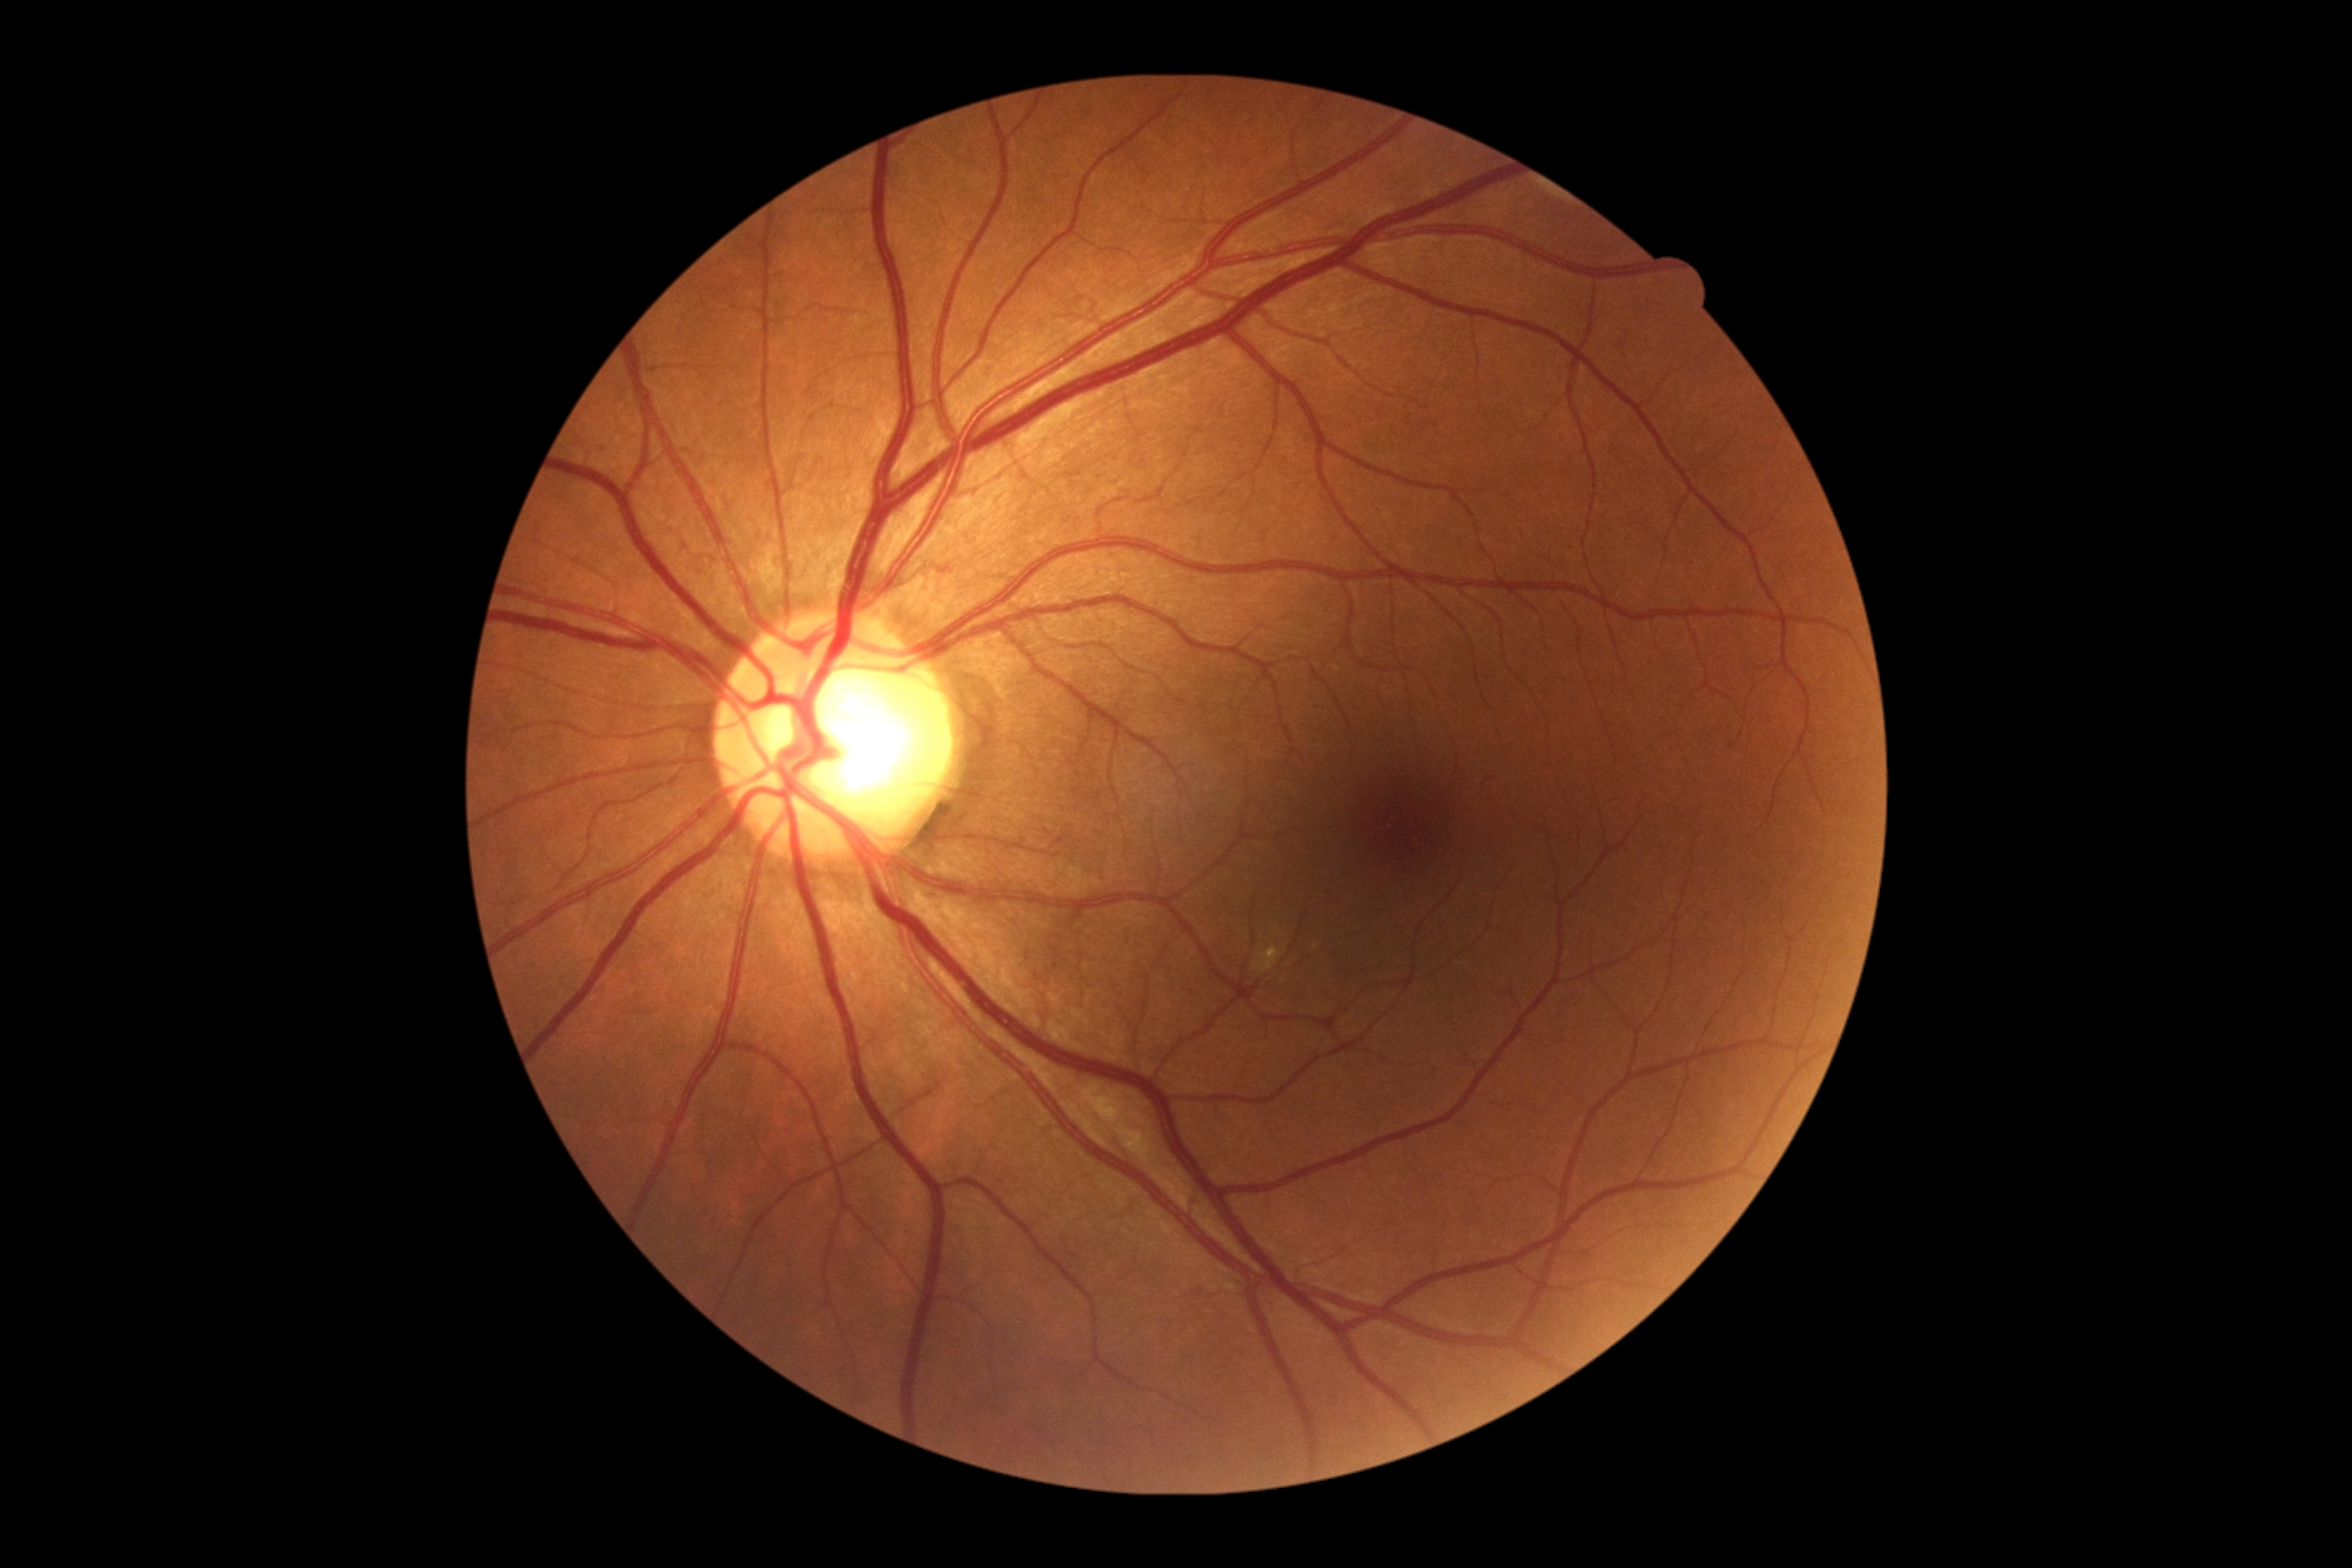
diabetic retinopathy (DR) = 0 | DR impression = no apparent DR.